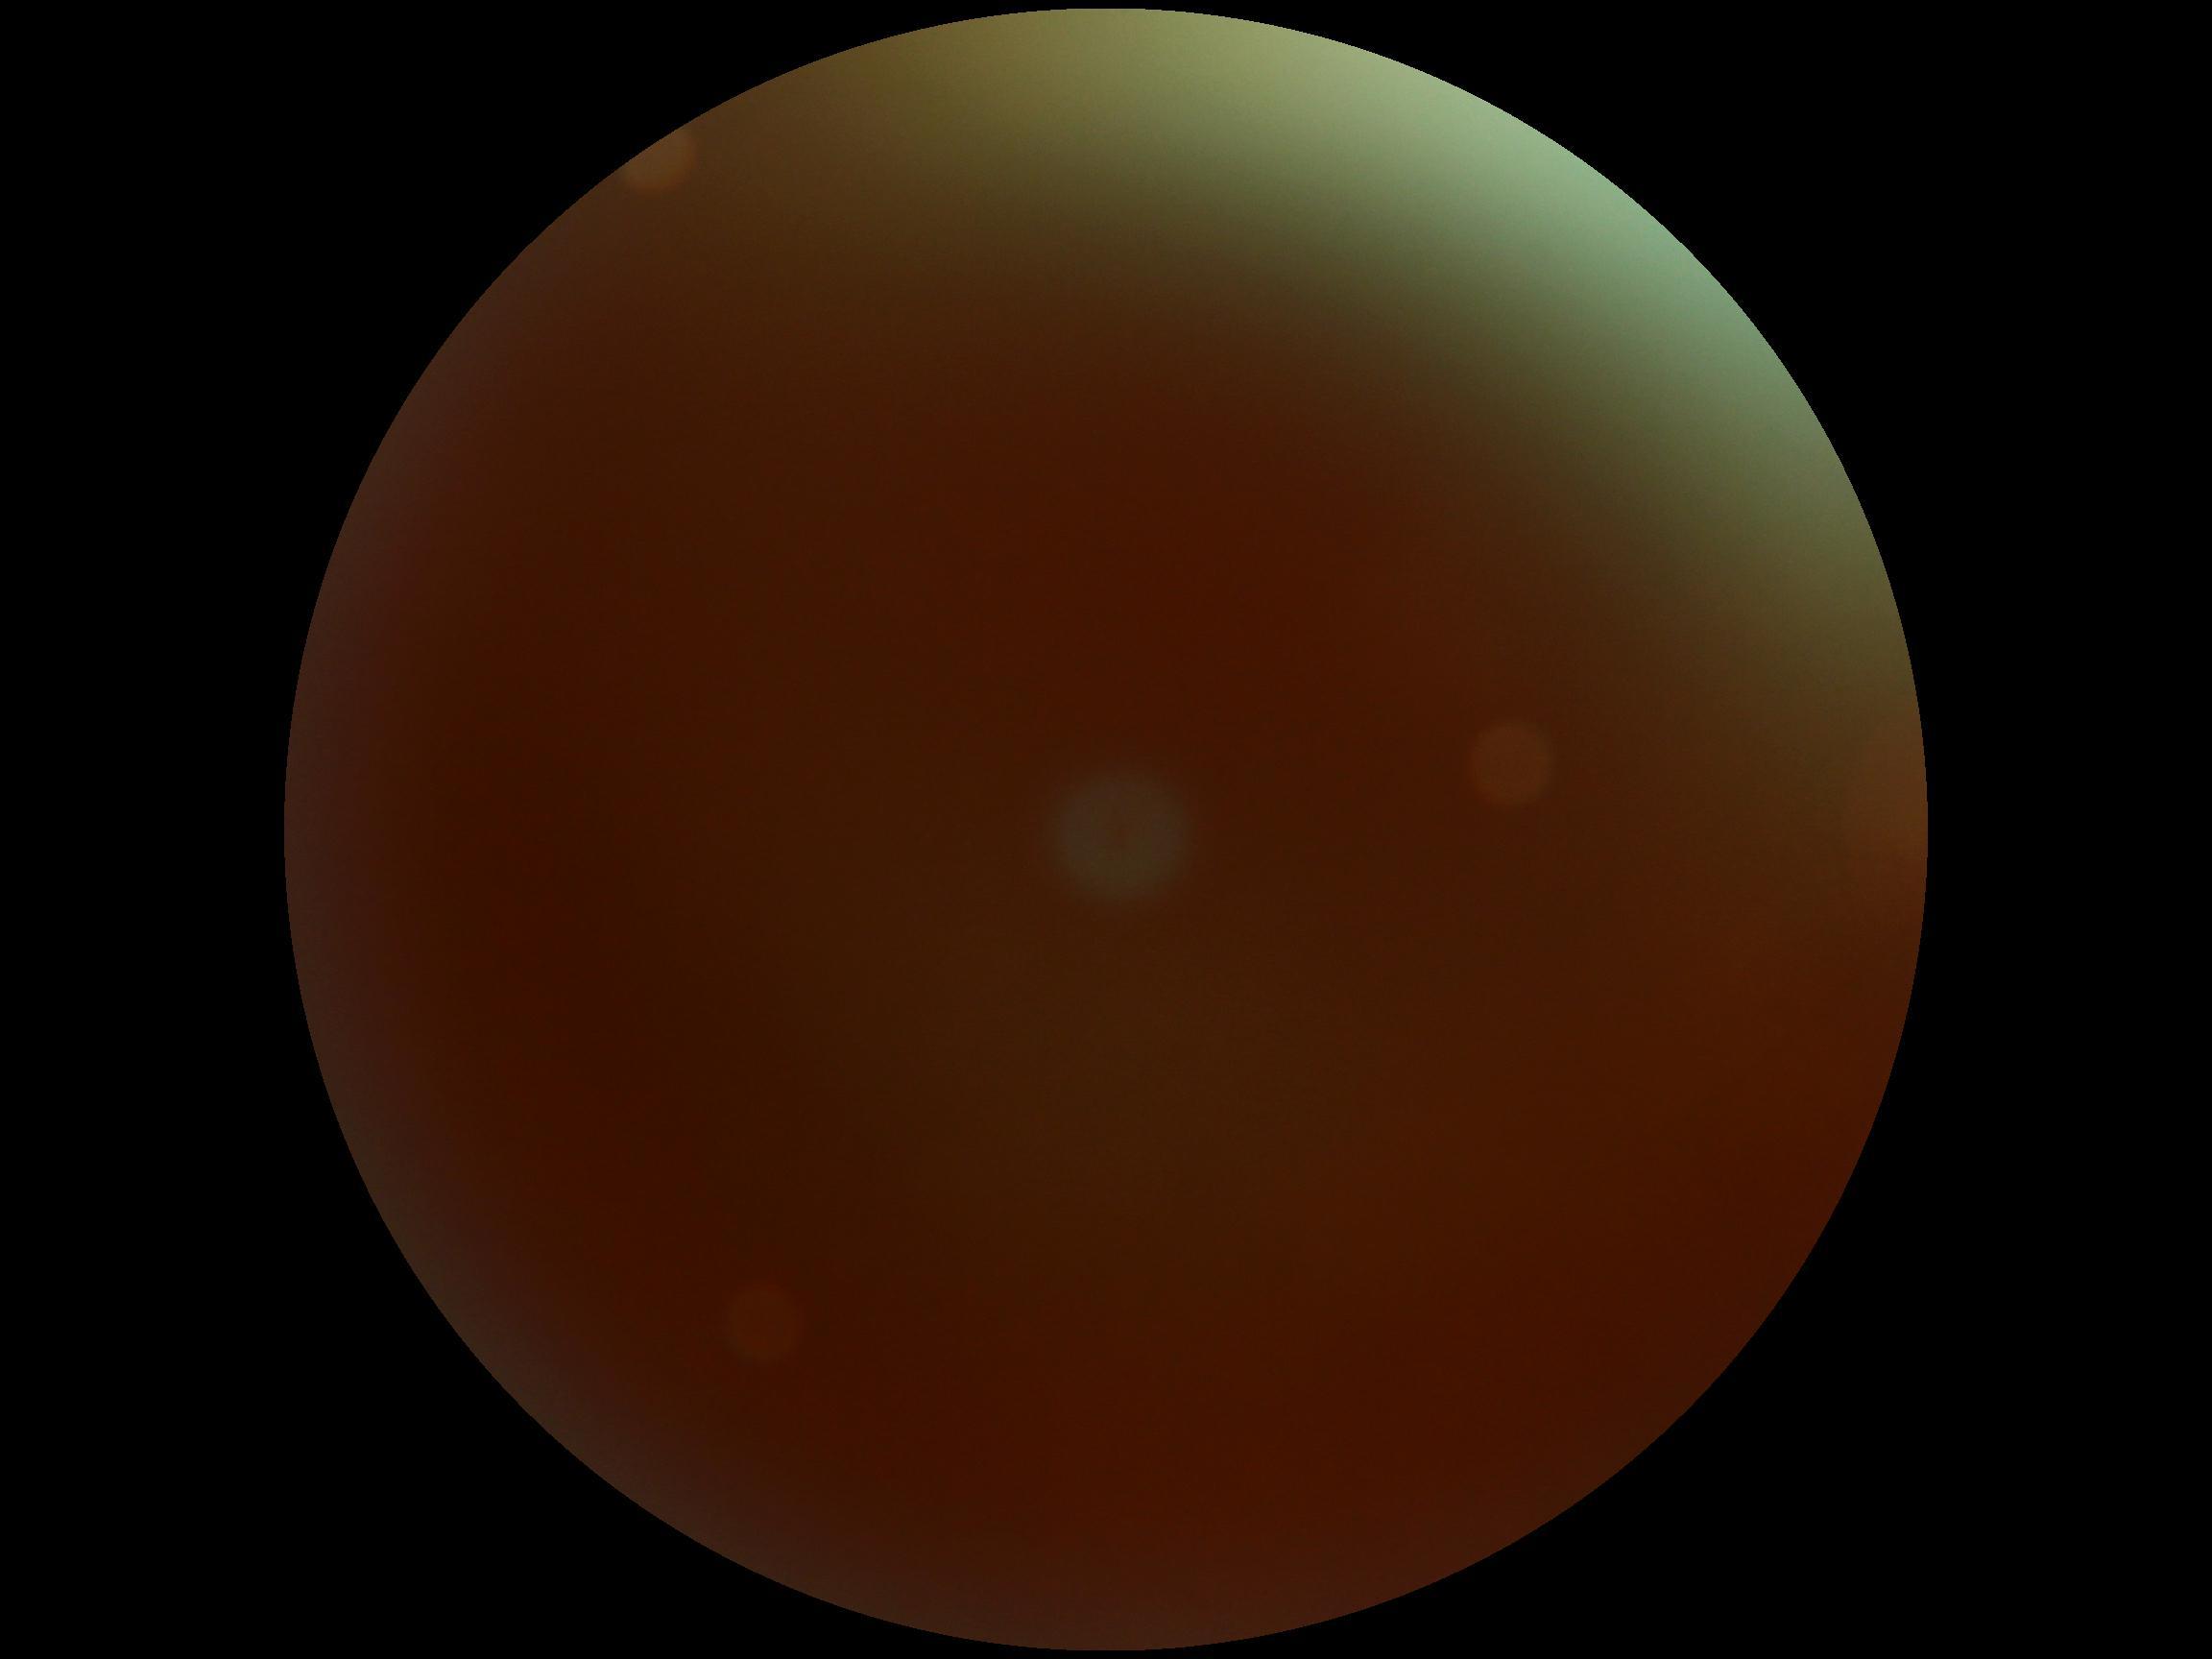

DR severity: ungradable due to poor image quality.